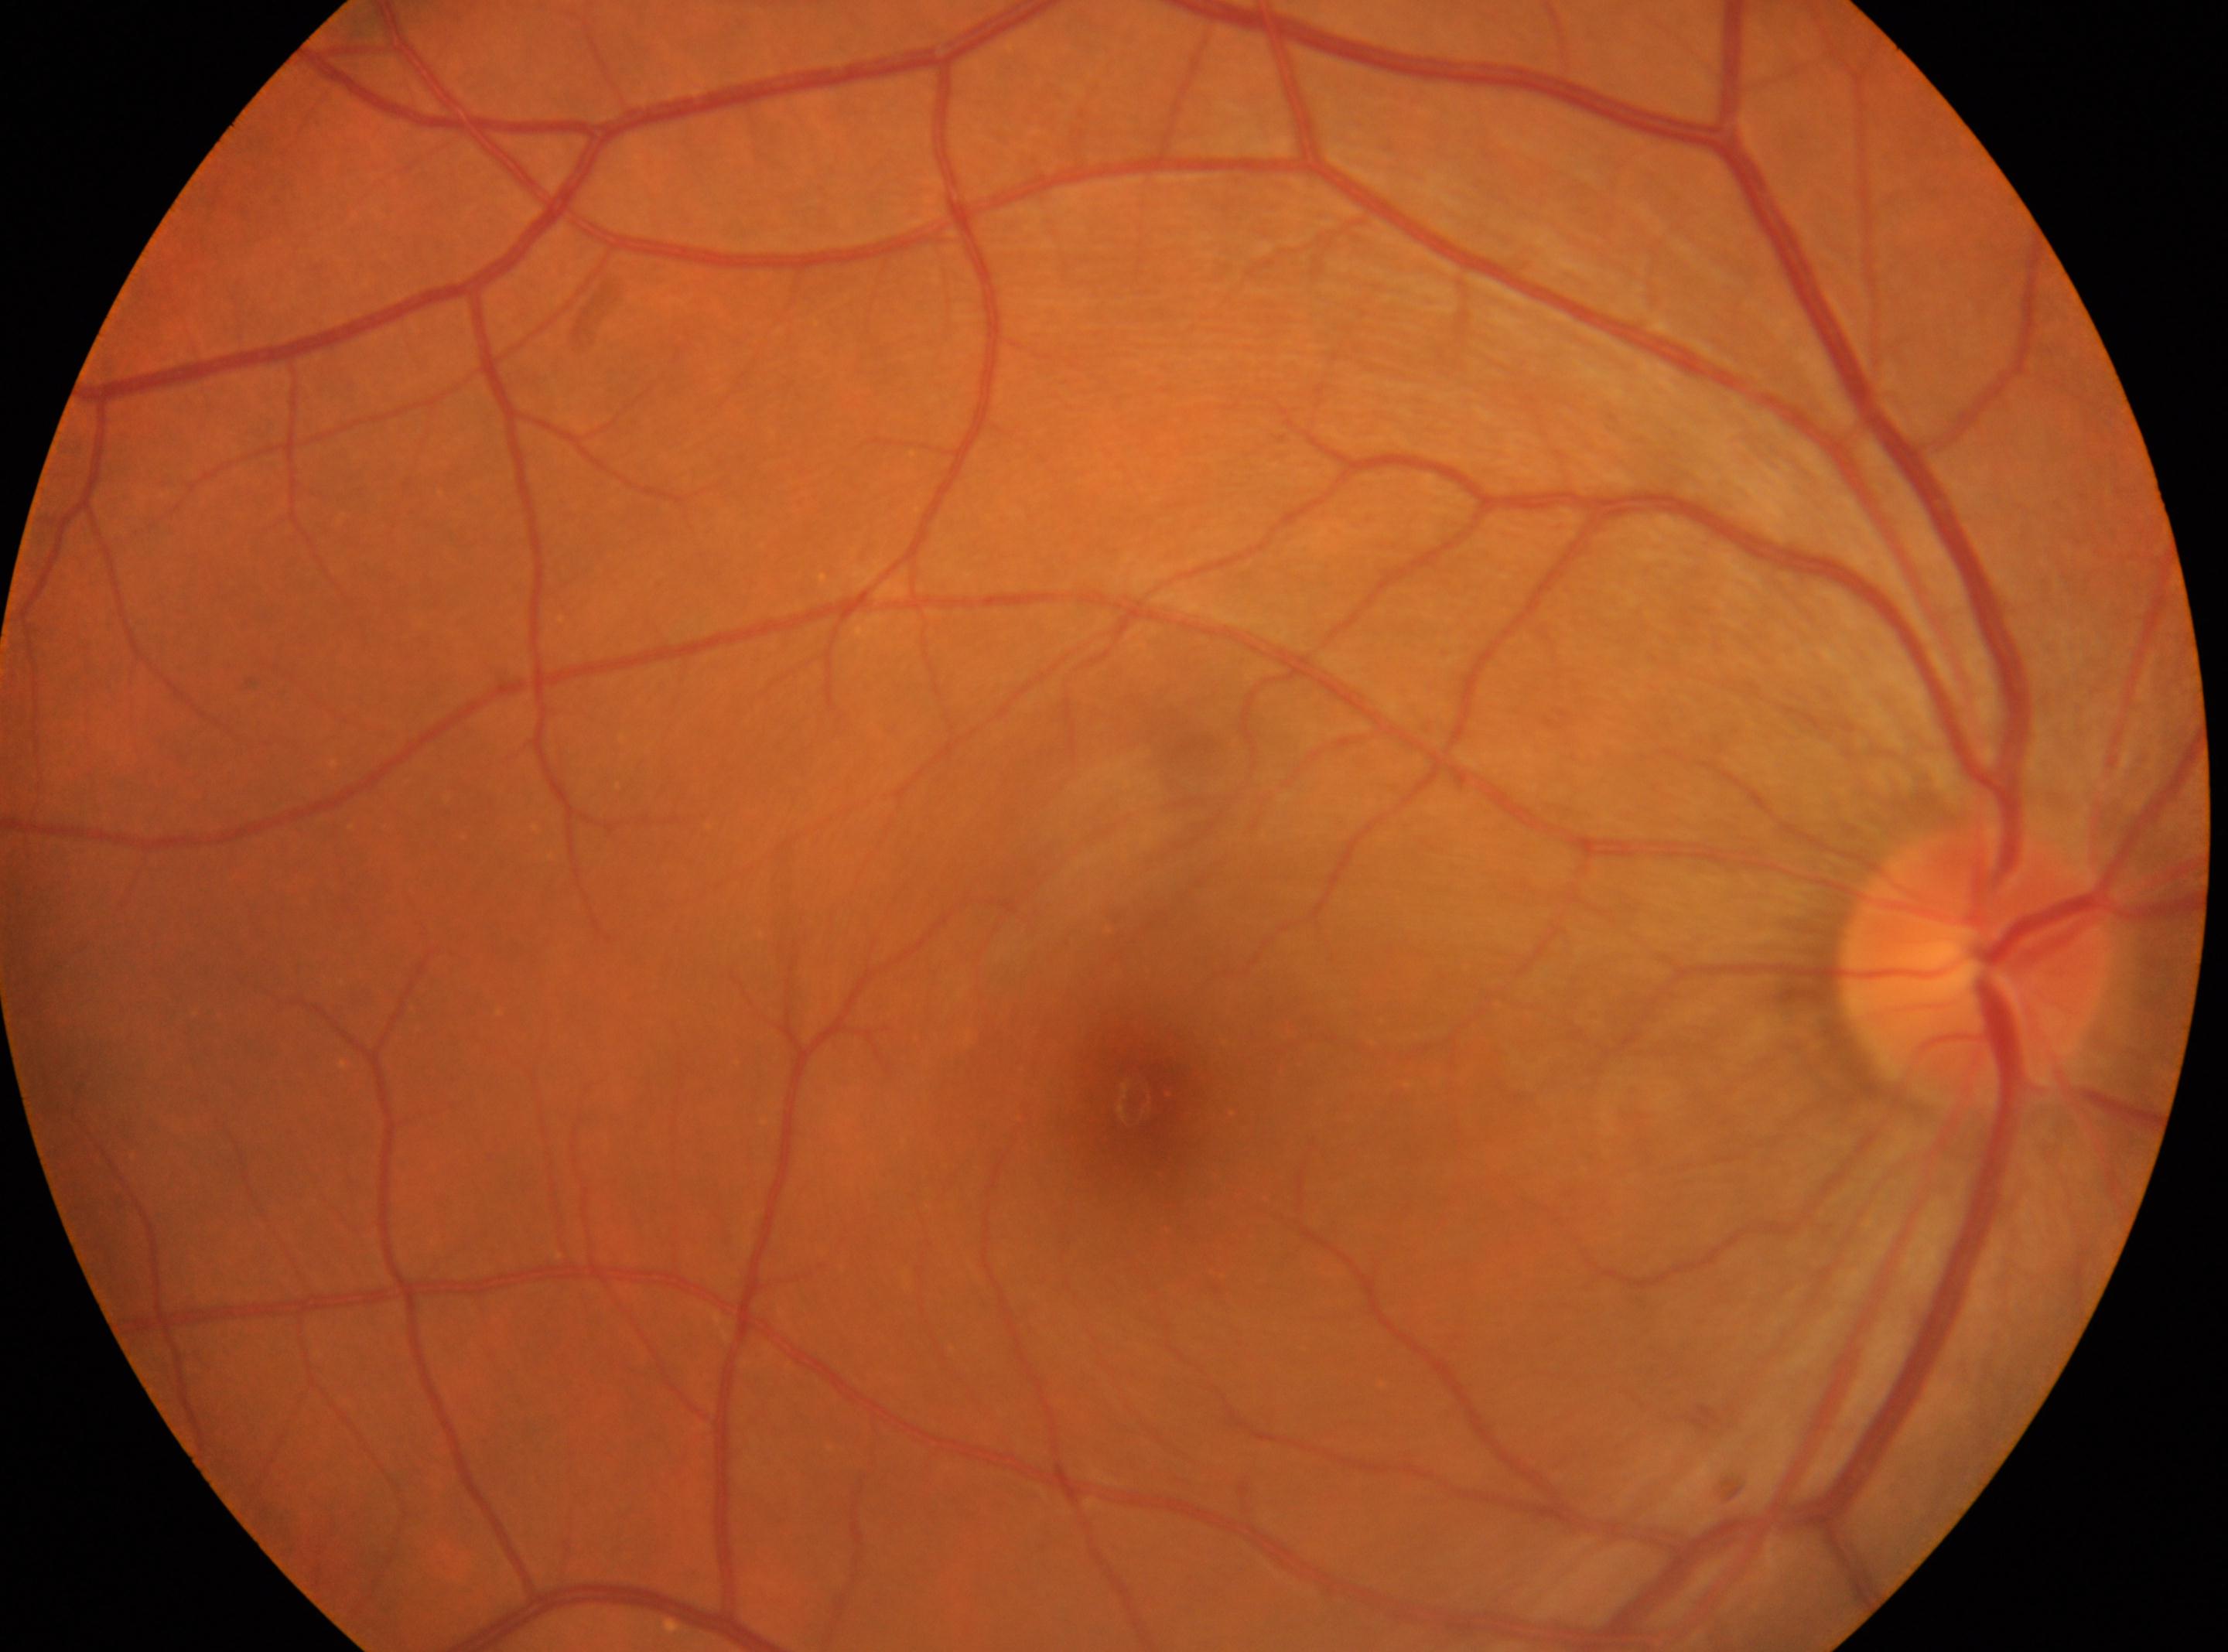
foveal center = (x=1146, y=1100), ONH = (x=1974, y=964), diabetic retinopathy severity = grade 0, laterality = the right eye.